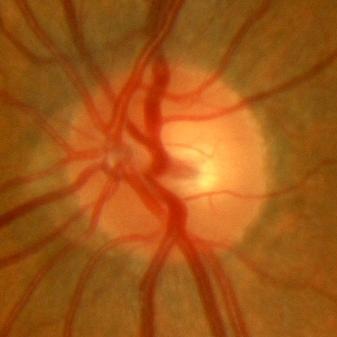

Optic disc photograph showing no glaucomatous changes.